FOV: 45 degrees
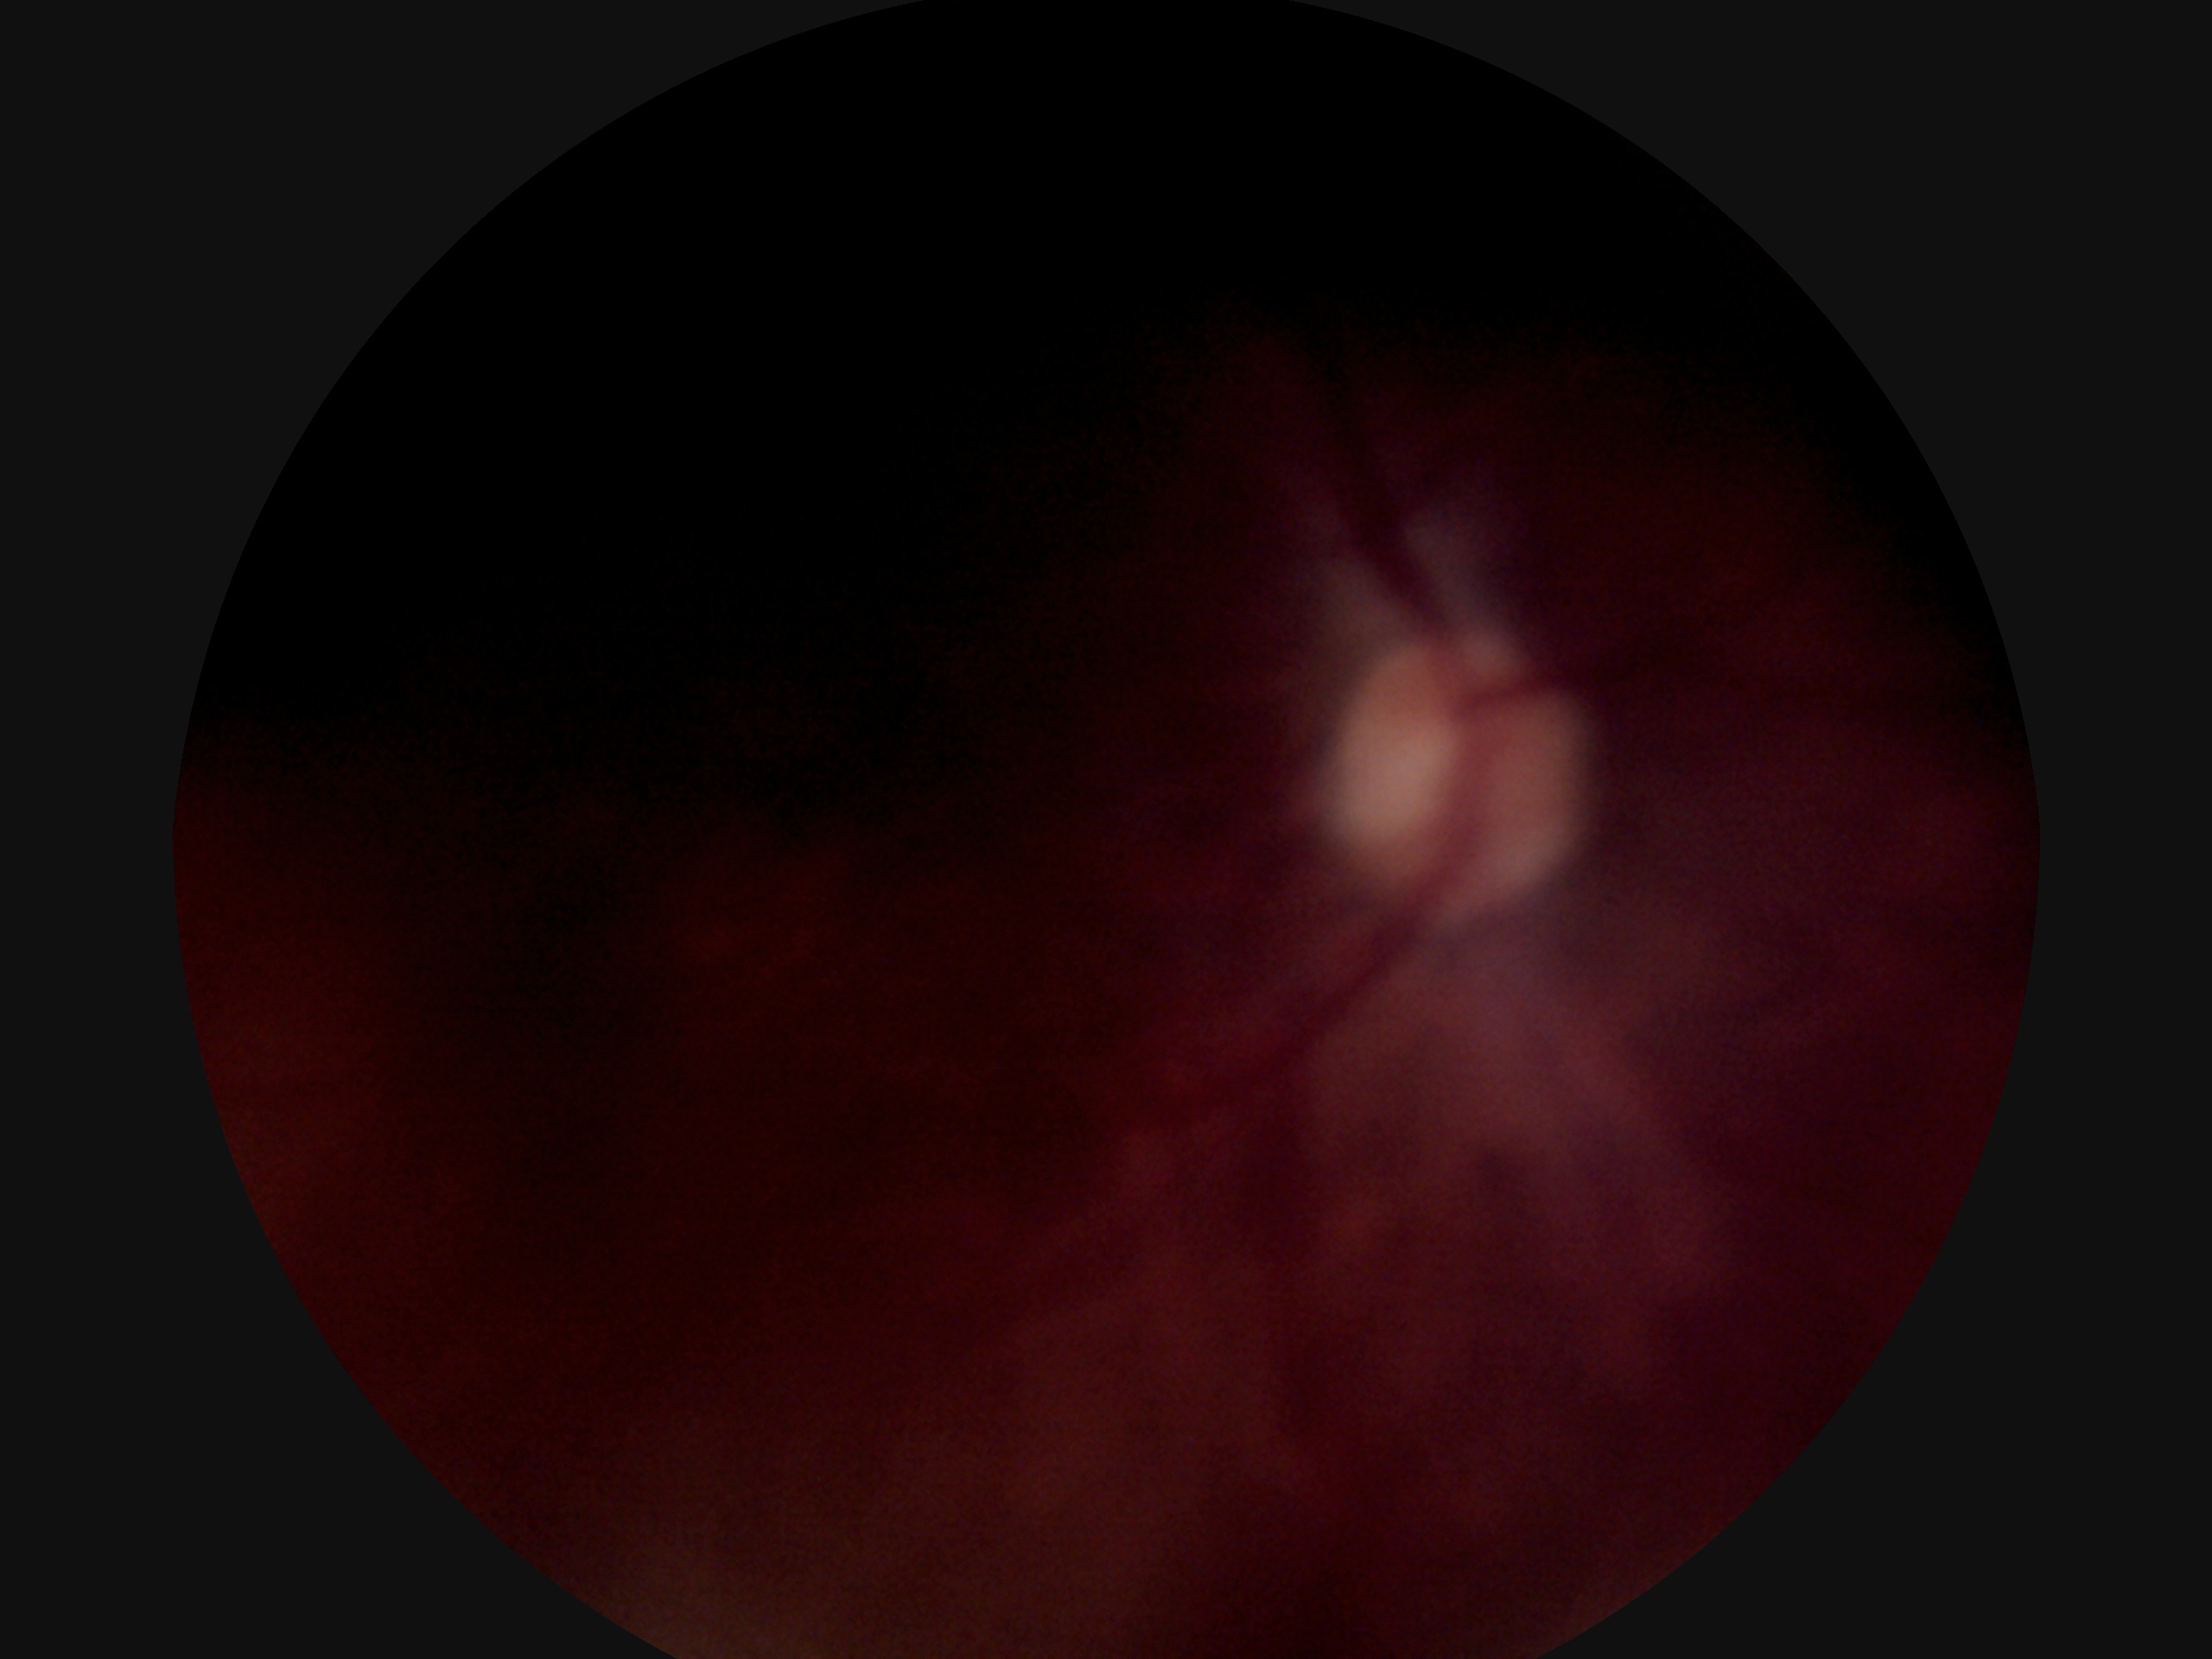

retinopathy grade: ungradable due to poor image quality.